CFP
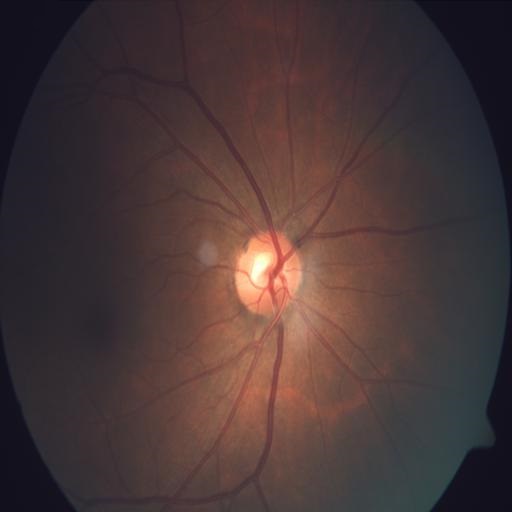
No abnormal findings on fundus examination.